50-degree field of view. 2228 by 1652 pixels: 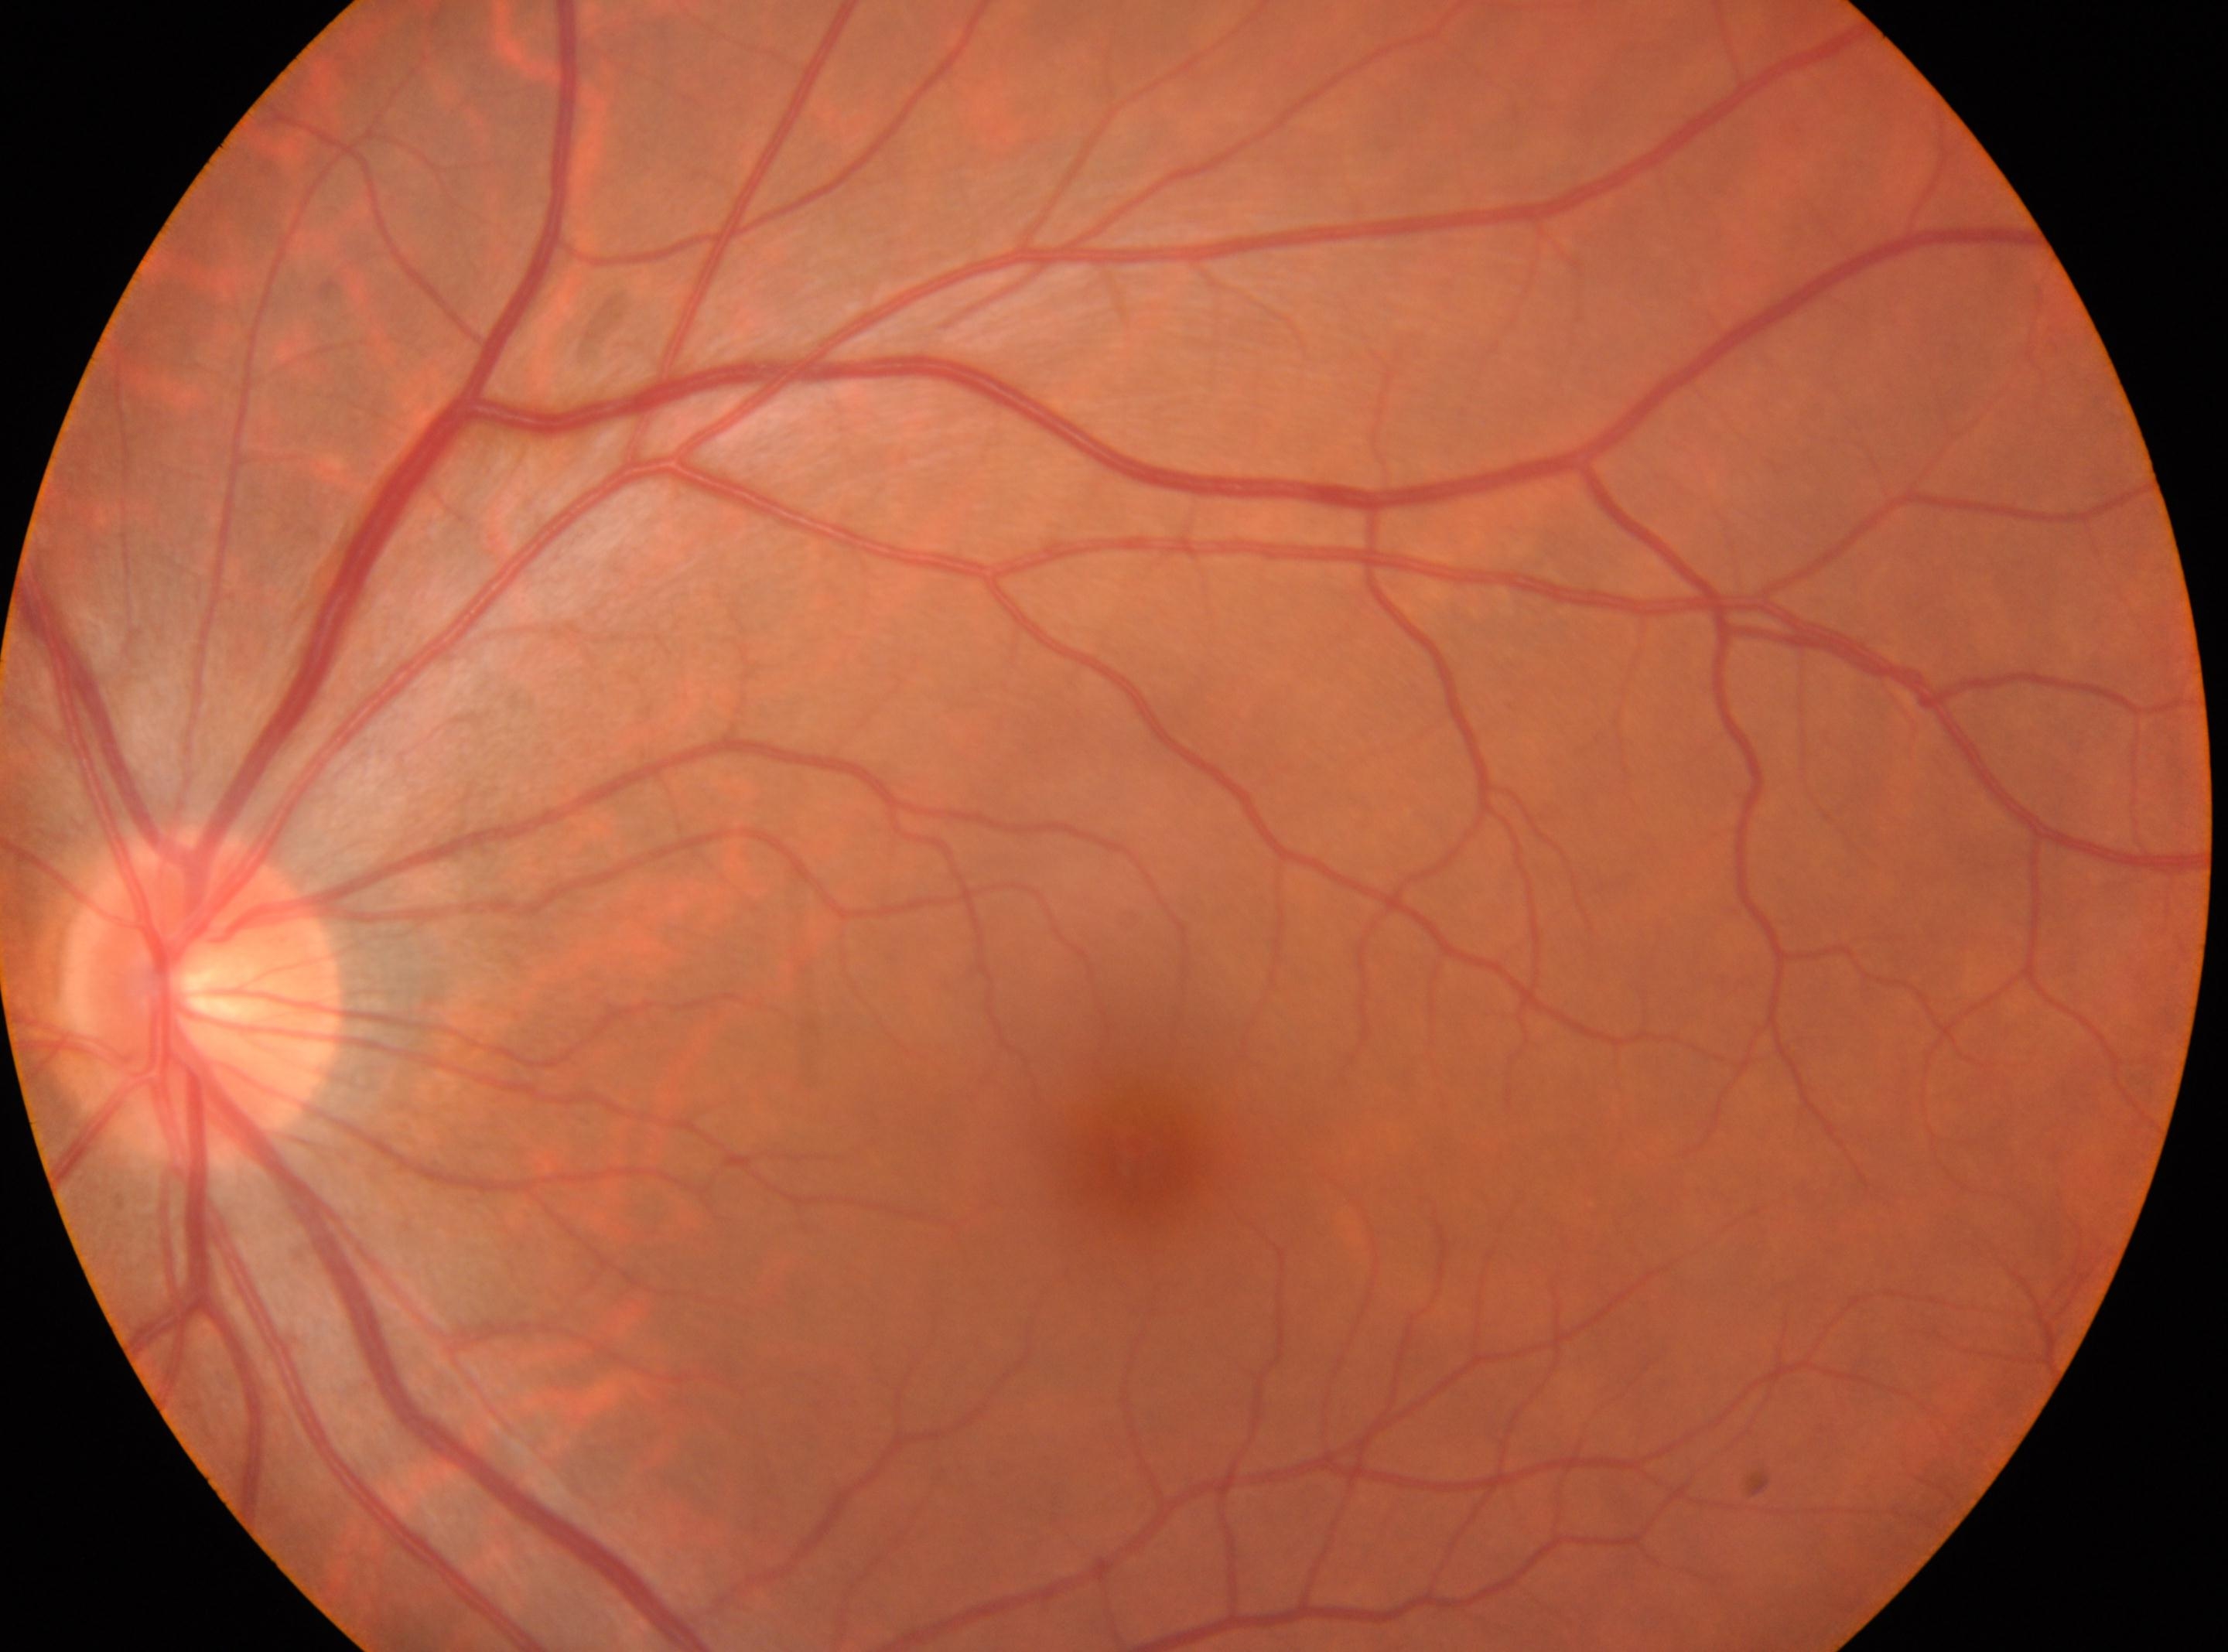

Optic disk located at 203, 991.
No DR findings.
Imaged eye: OS.
Foveal center located at 1142, 1151.
Diabetic retinopathy severity is 0 — no visible signs of diabetic retinopathy.